Clarity RetCam 3, 130° FOV; infant wide-field fundus photograph — 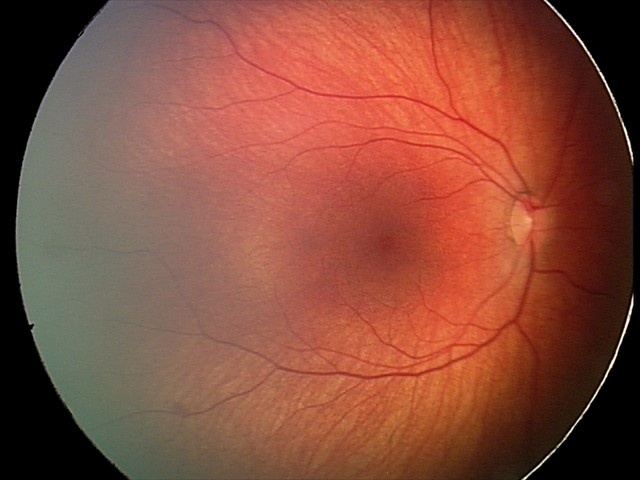

Impression: retinal hemorrhages.